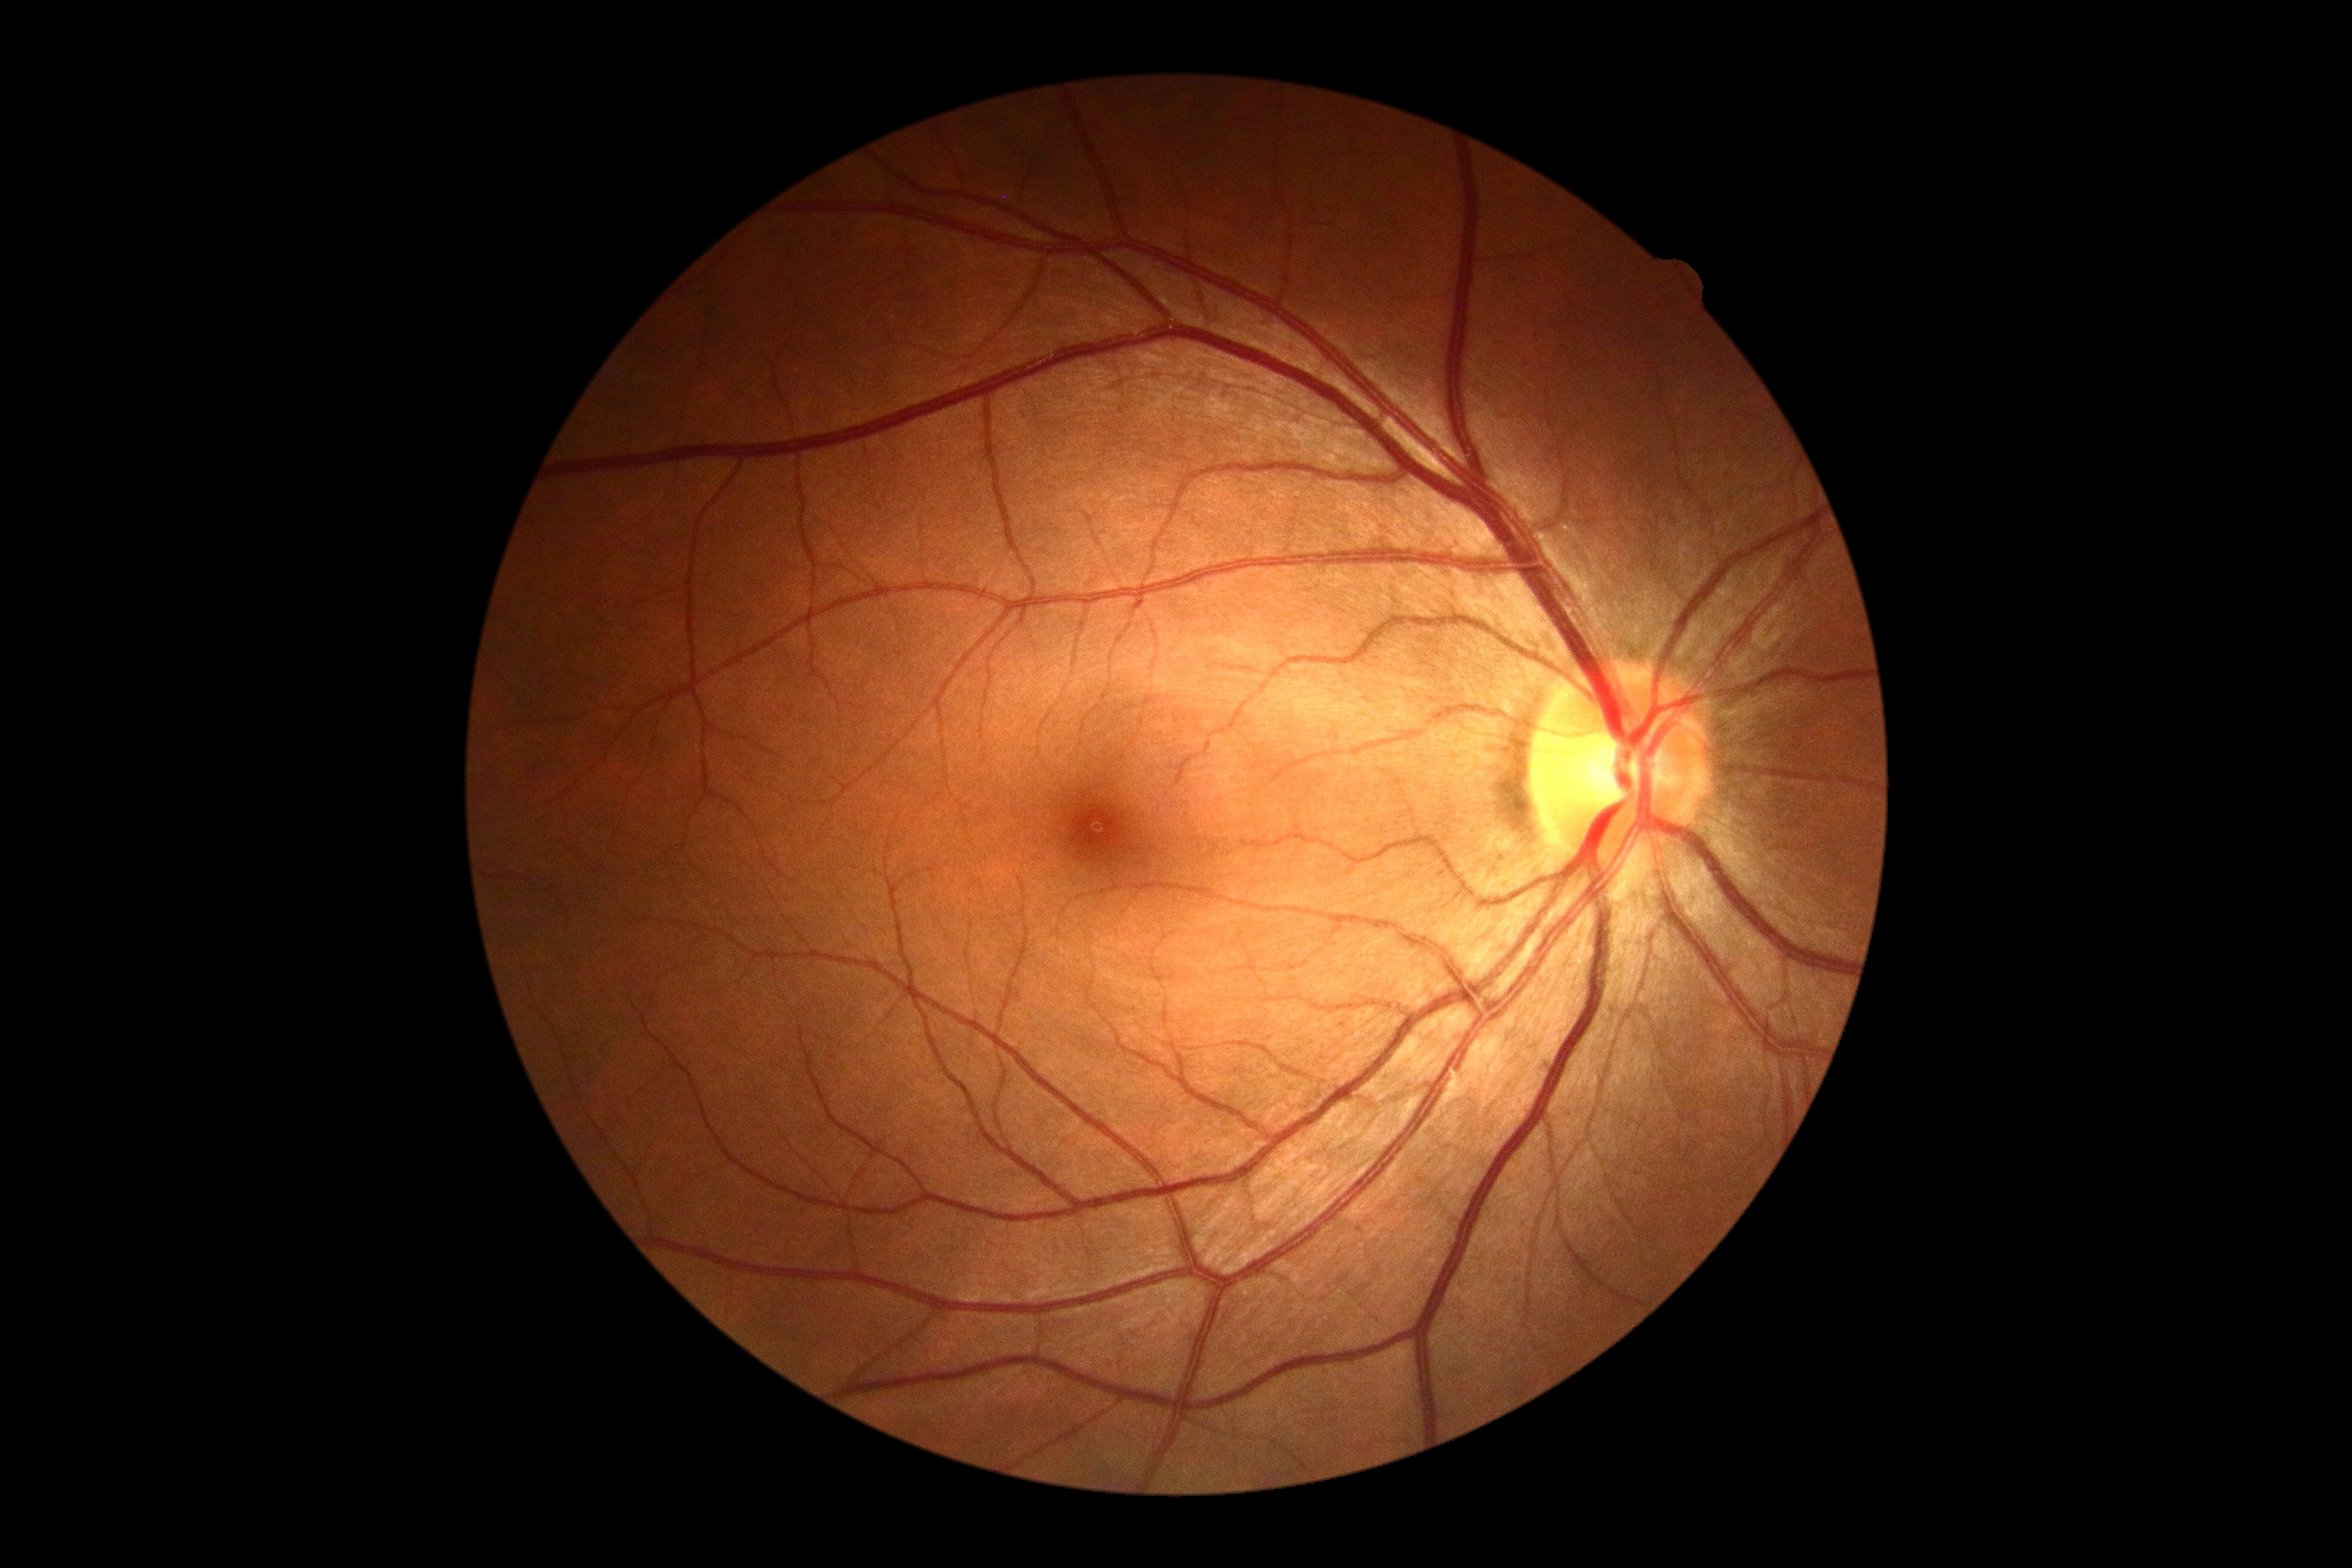

diabetic retinopathy (DR): no apparent diabetic retinopathy (grade 0).